Retinal fundus photograph
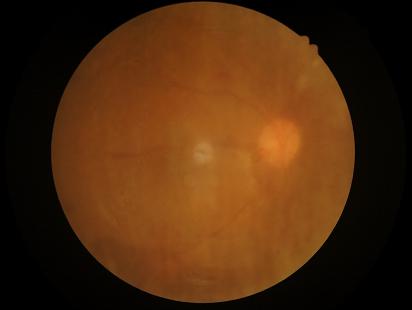 Quality assessment: illumination: satisfactory | contrast: poor | overall: low | clarity: blurry.